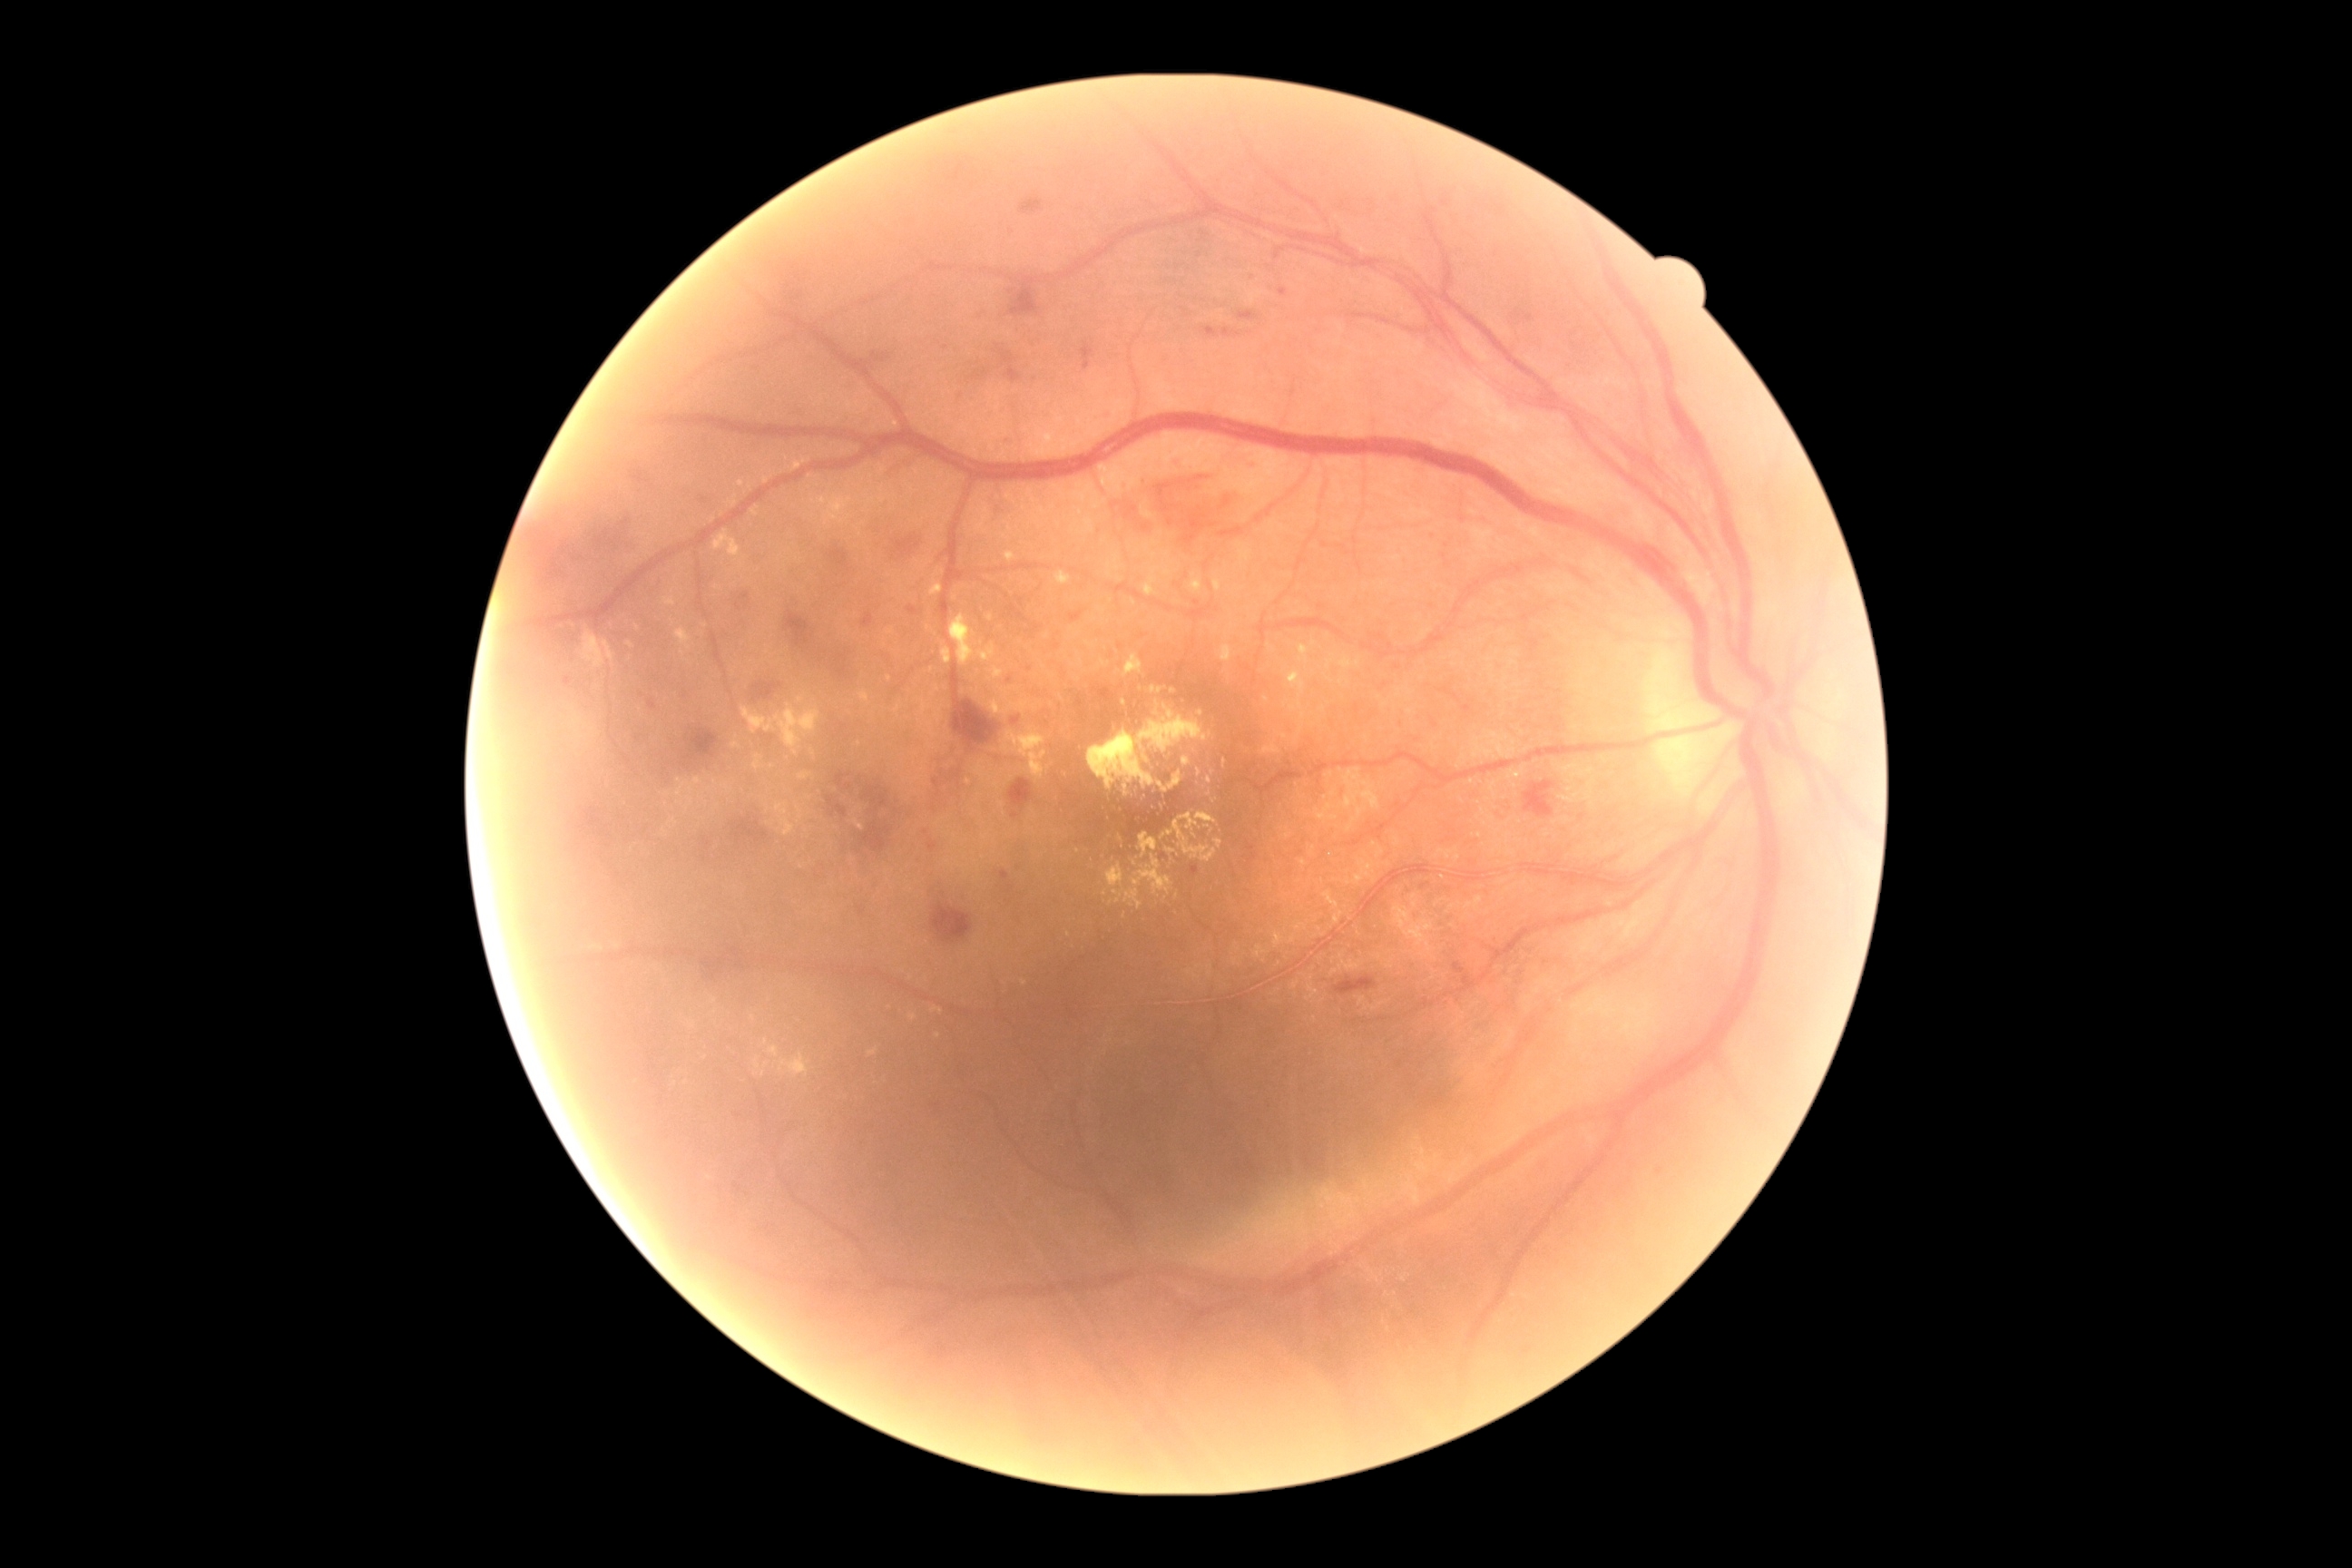 Diabetic retinopathy (DR) is moderate NPDR (grade 2)
Selected lesions:
hard exudates (EXs) (partial): [left=1161, top=830, right=1175, bottom=841]; [left=1122, top=654, right=1144, bottom=678]; [left=936, top=569, right=945, bottom=576]; [left=1144, top=567, right=1173, bottom=596]; [left=1055, top=573, right=1072, bottom=585]; [left=763, top=476, right=769, bottom=484]; [left=854, top=819, right=865, bottom=830]; [left=879, top=487, right=897, bottom=504]; [left=1006, top=553, right=1015, bottom=562]; [left=1173, top=812, right=1228, bottom=867]
Small EXs approximately at x=772 y=767; x=1341 y=683; x=925 y=567; x=1208 y=826; x=1296 y=946; x=938 y=1036; x=683 y=653; x=599 y=688